CFP. 45-degree field of view — 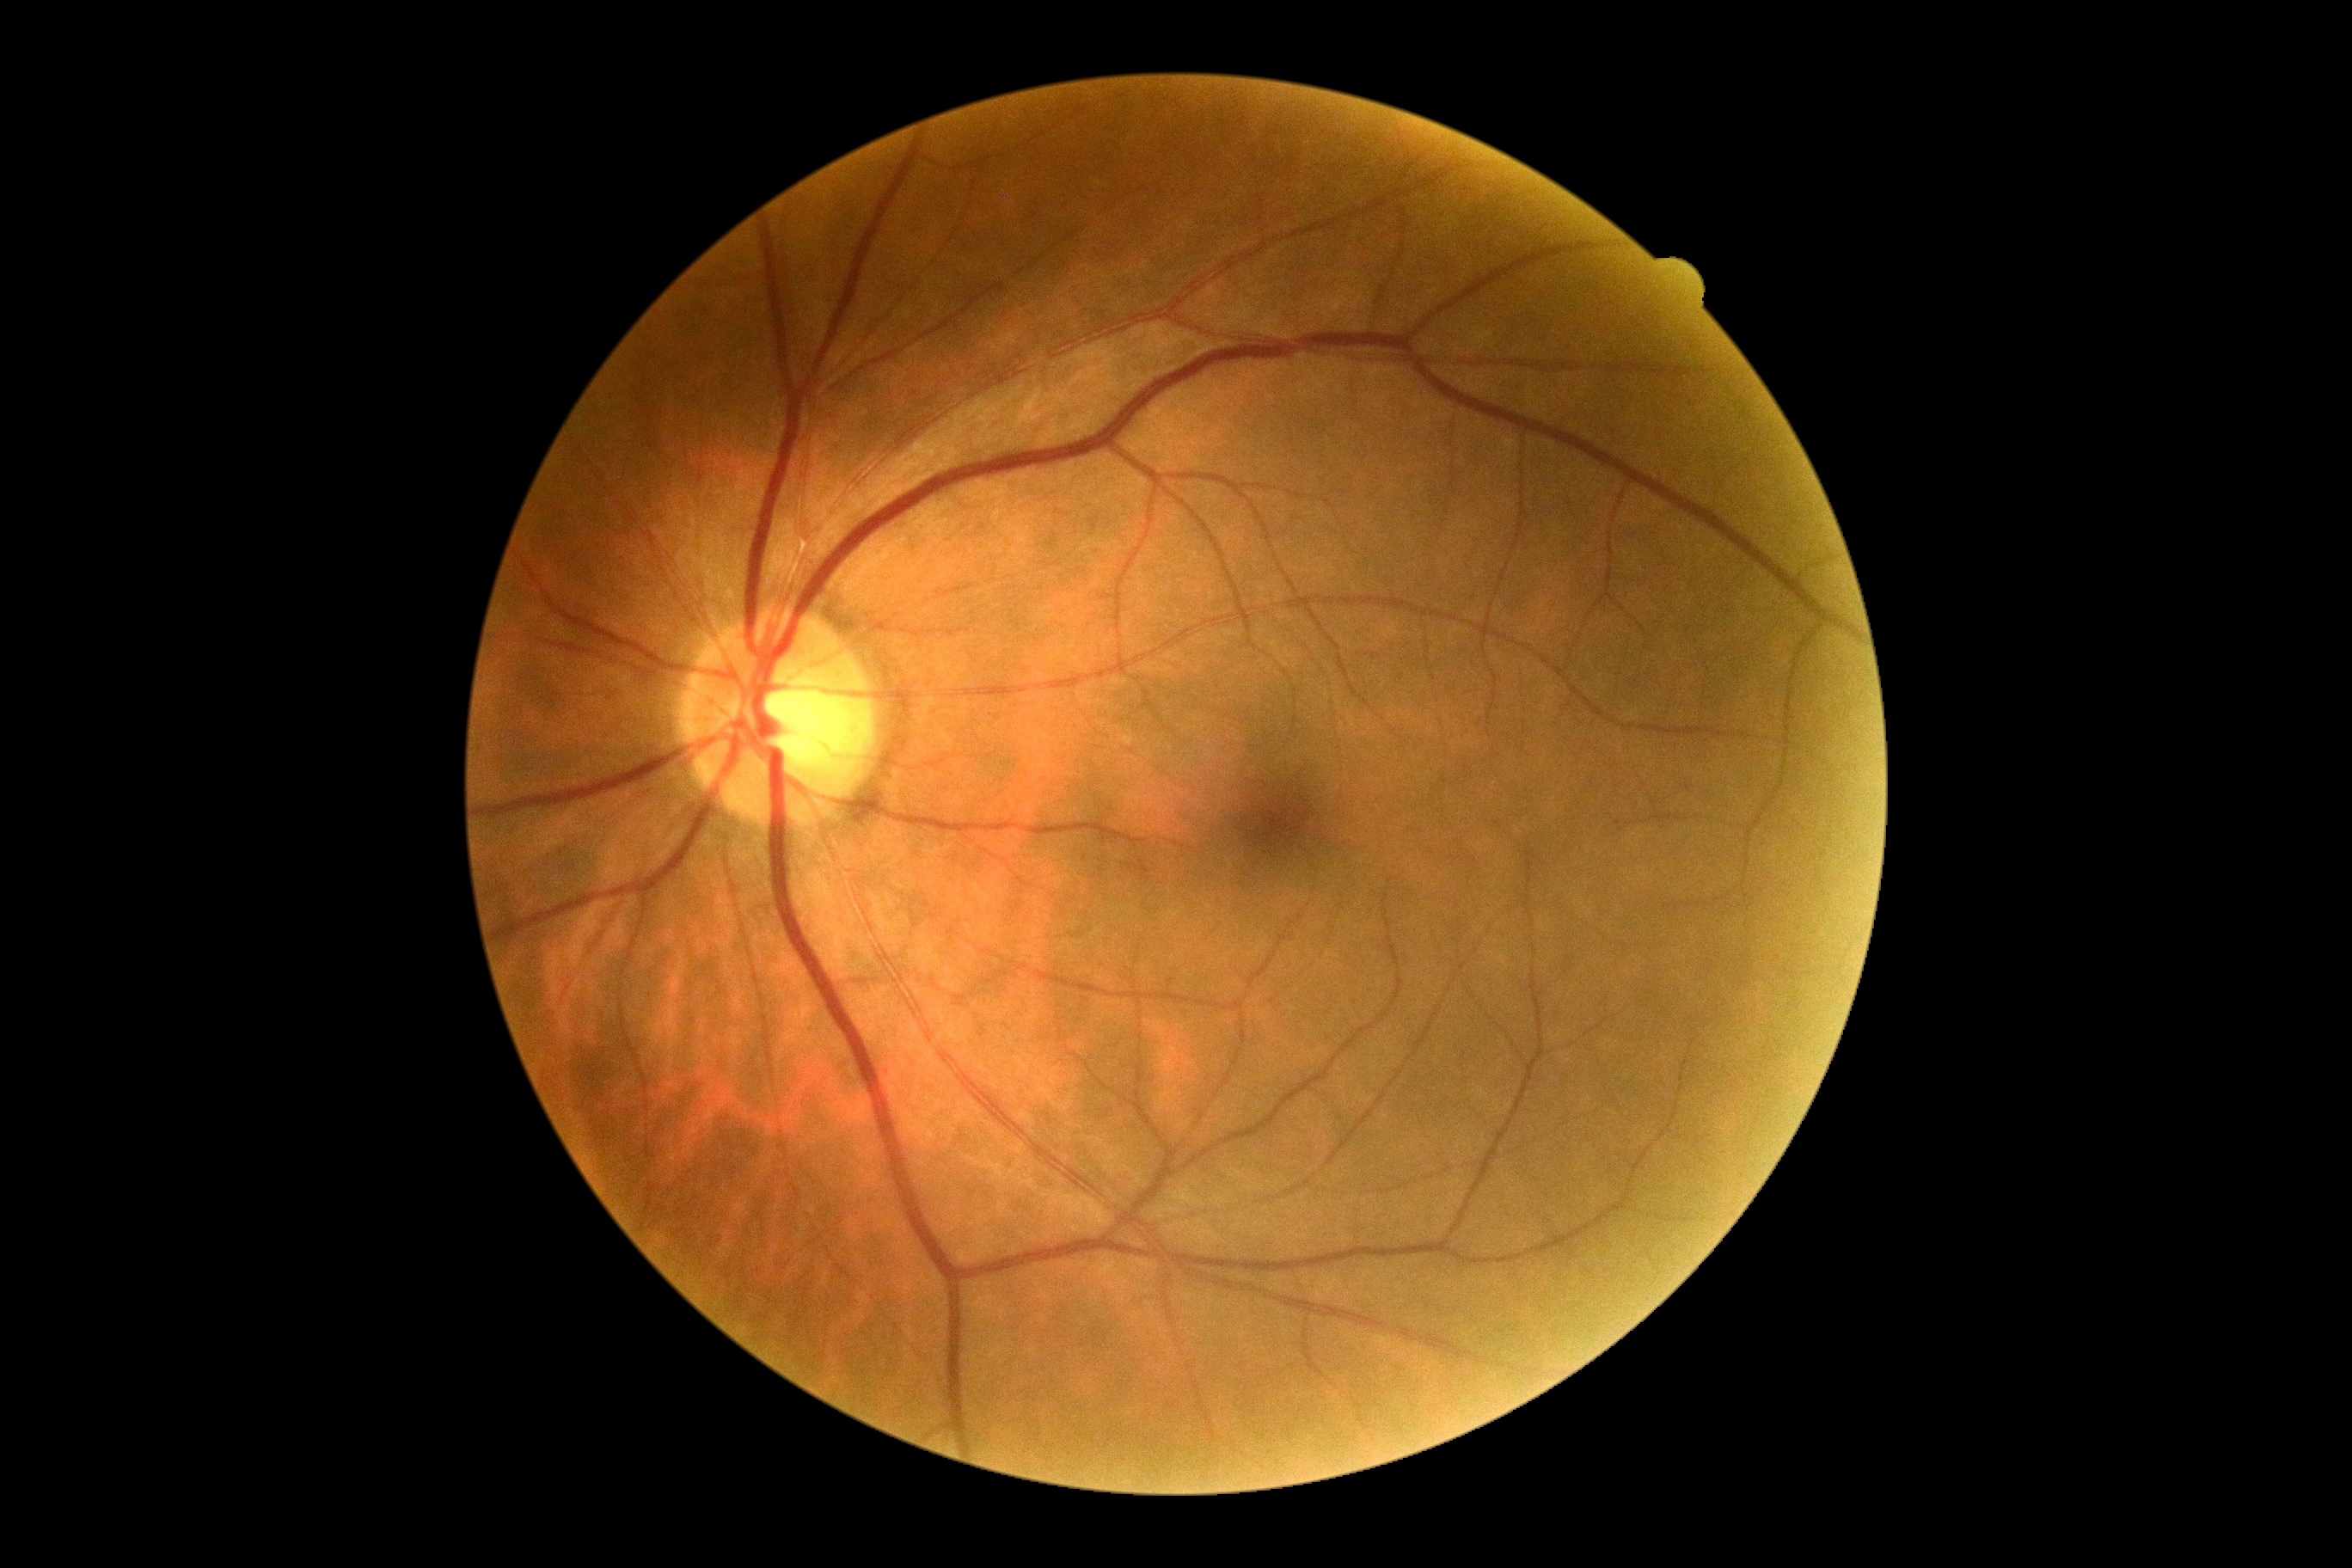 DR stage is no apparent retinopathy (grade 0) — no visible signs of diabetic retinopathy.
No apparent diabetic retinopathy.